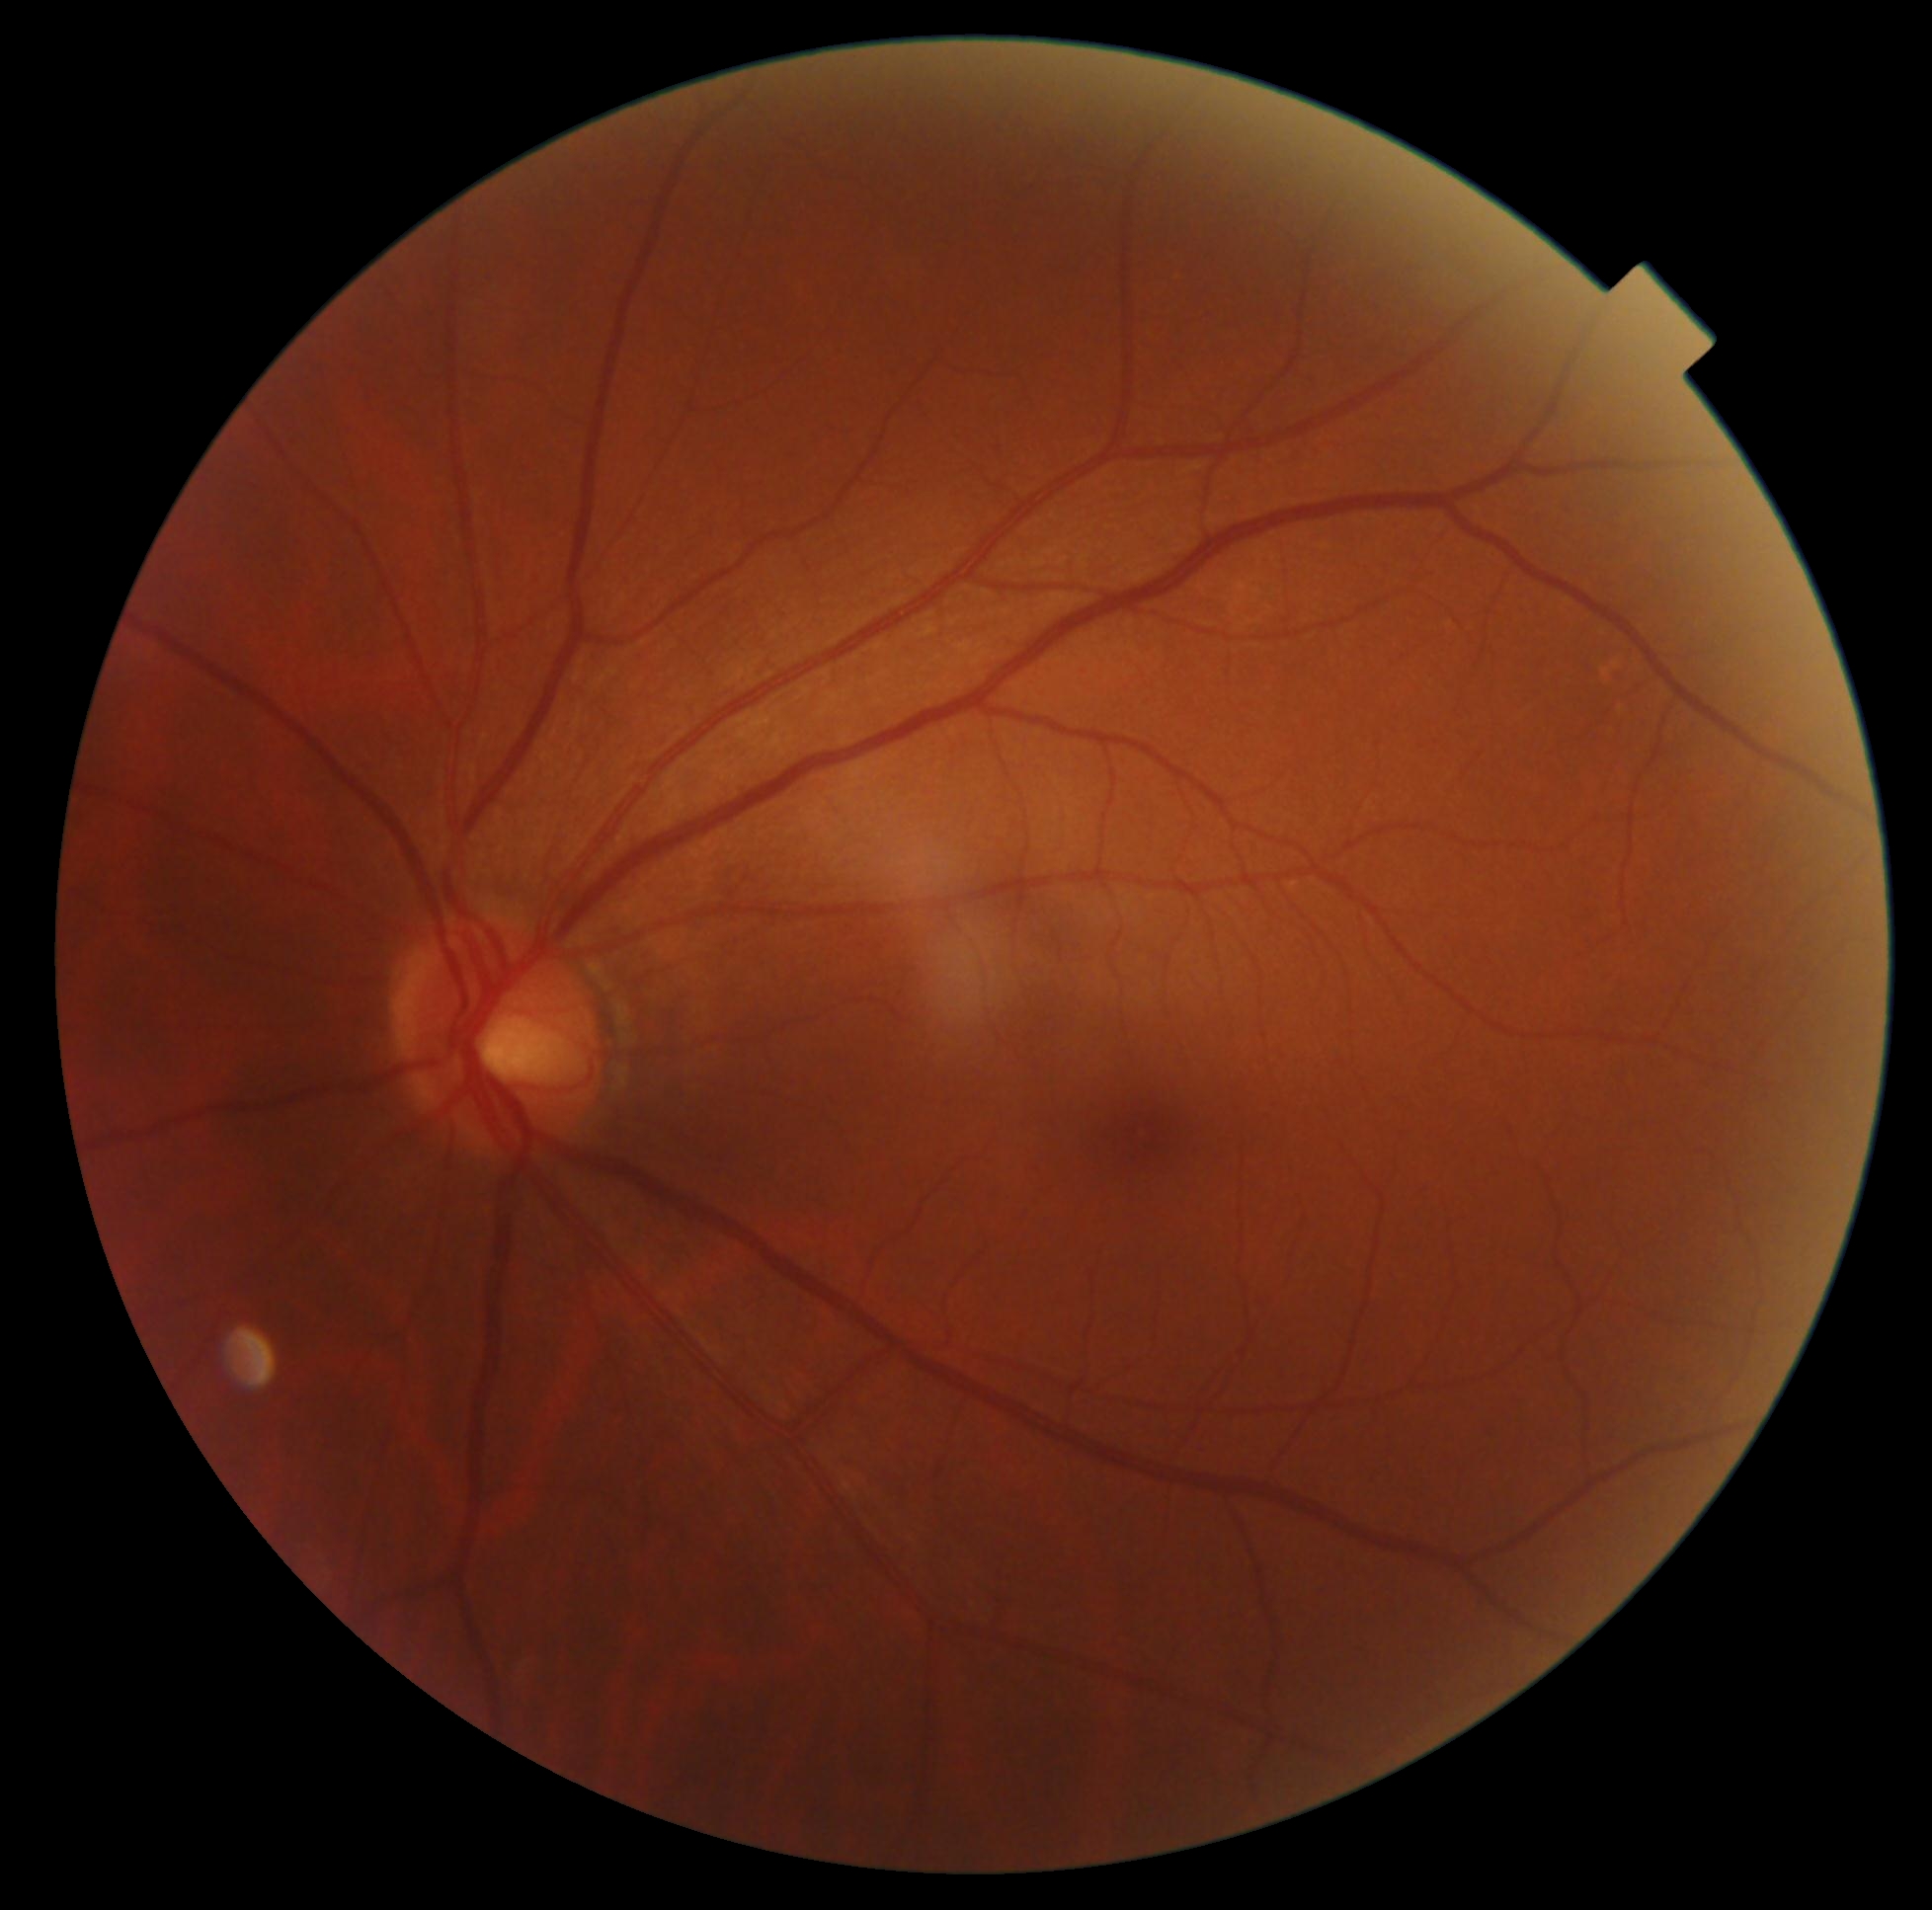
Annotations:
- DR — no apparent diabetic retinopathy (grade 0)